2212x1659
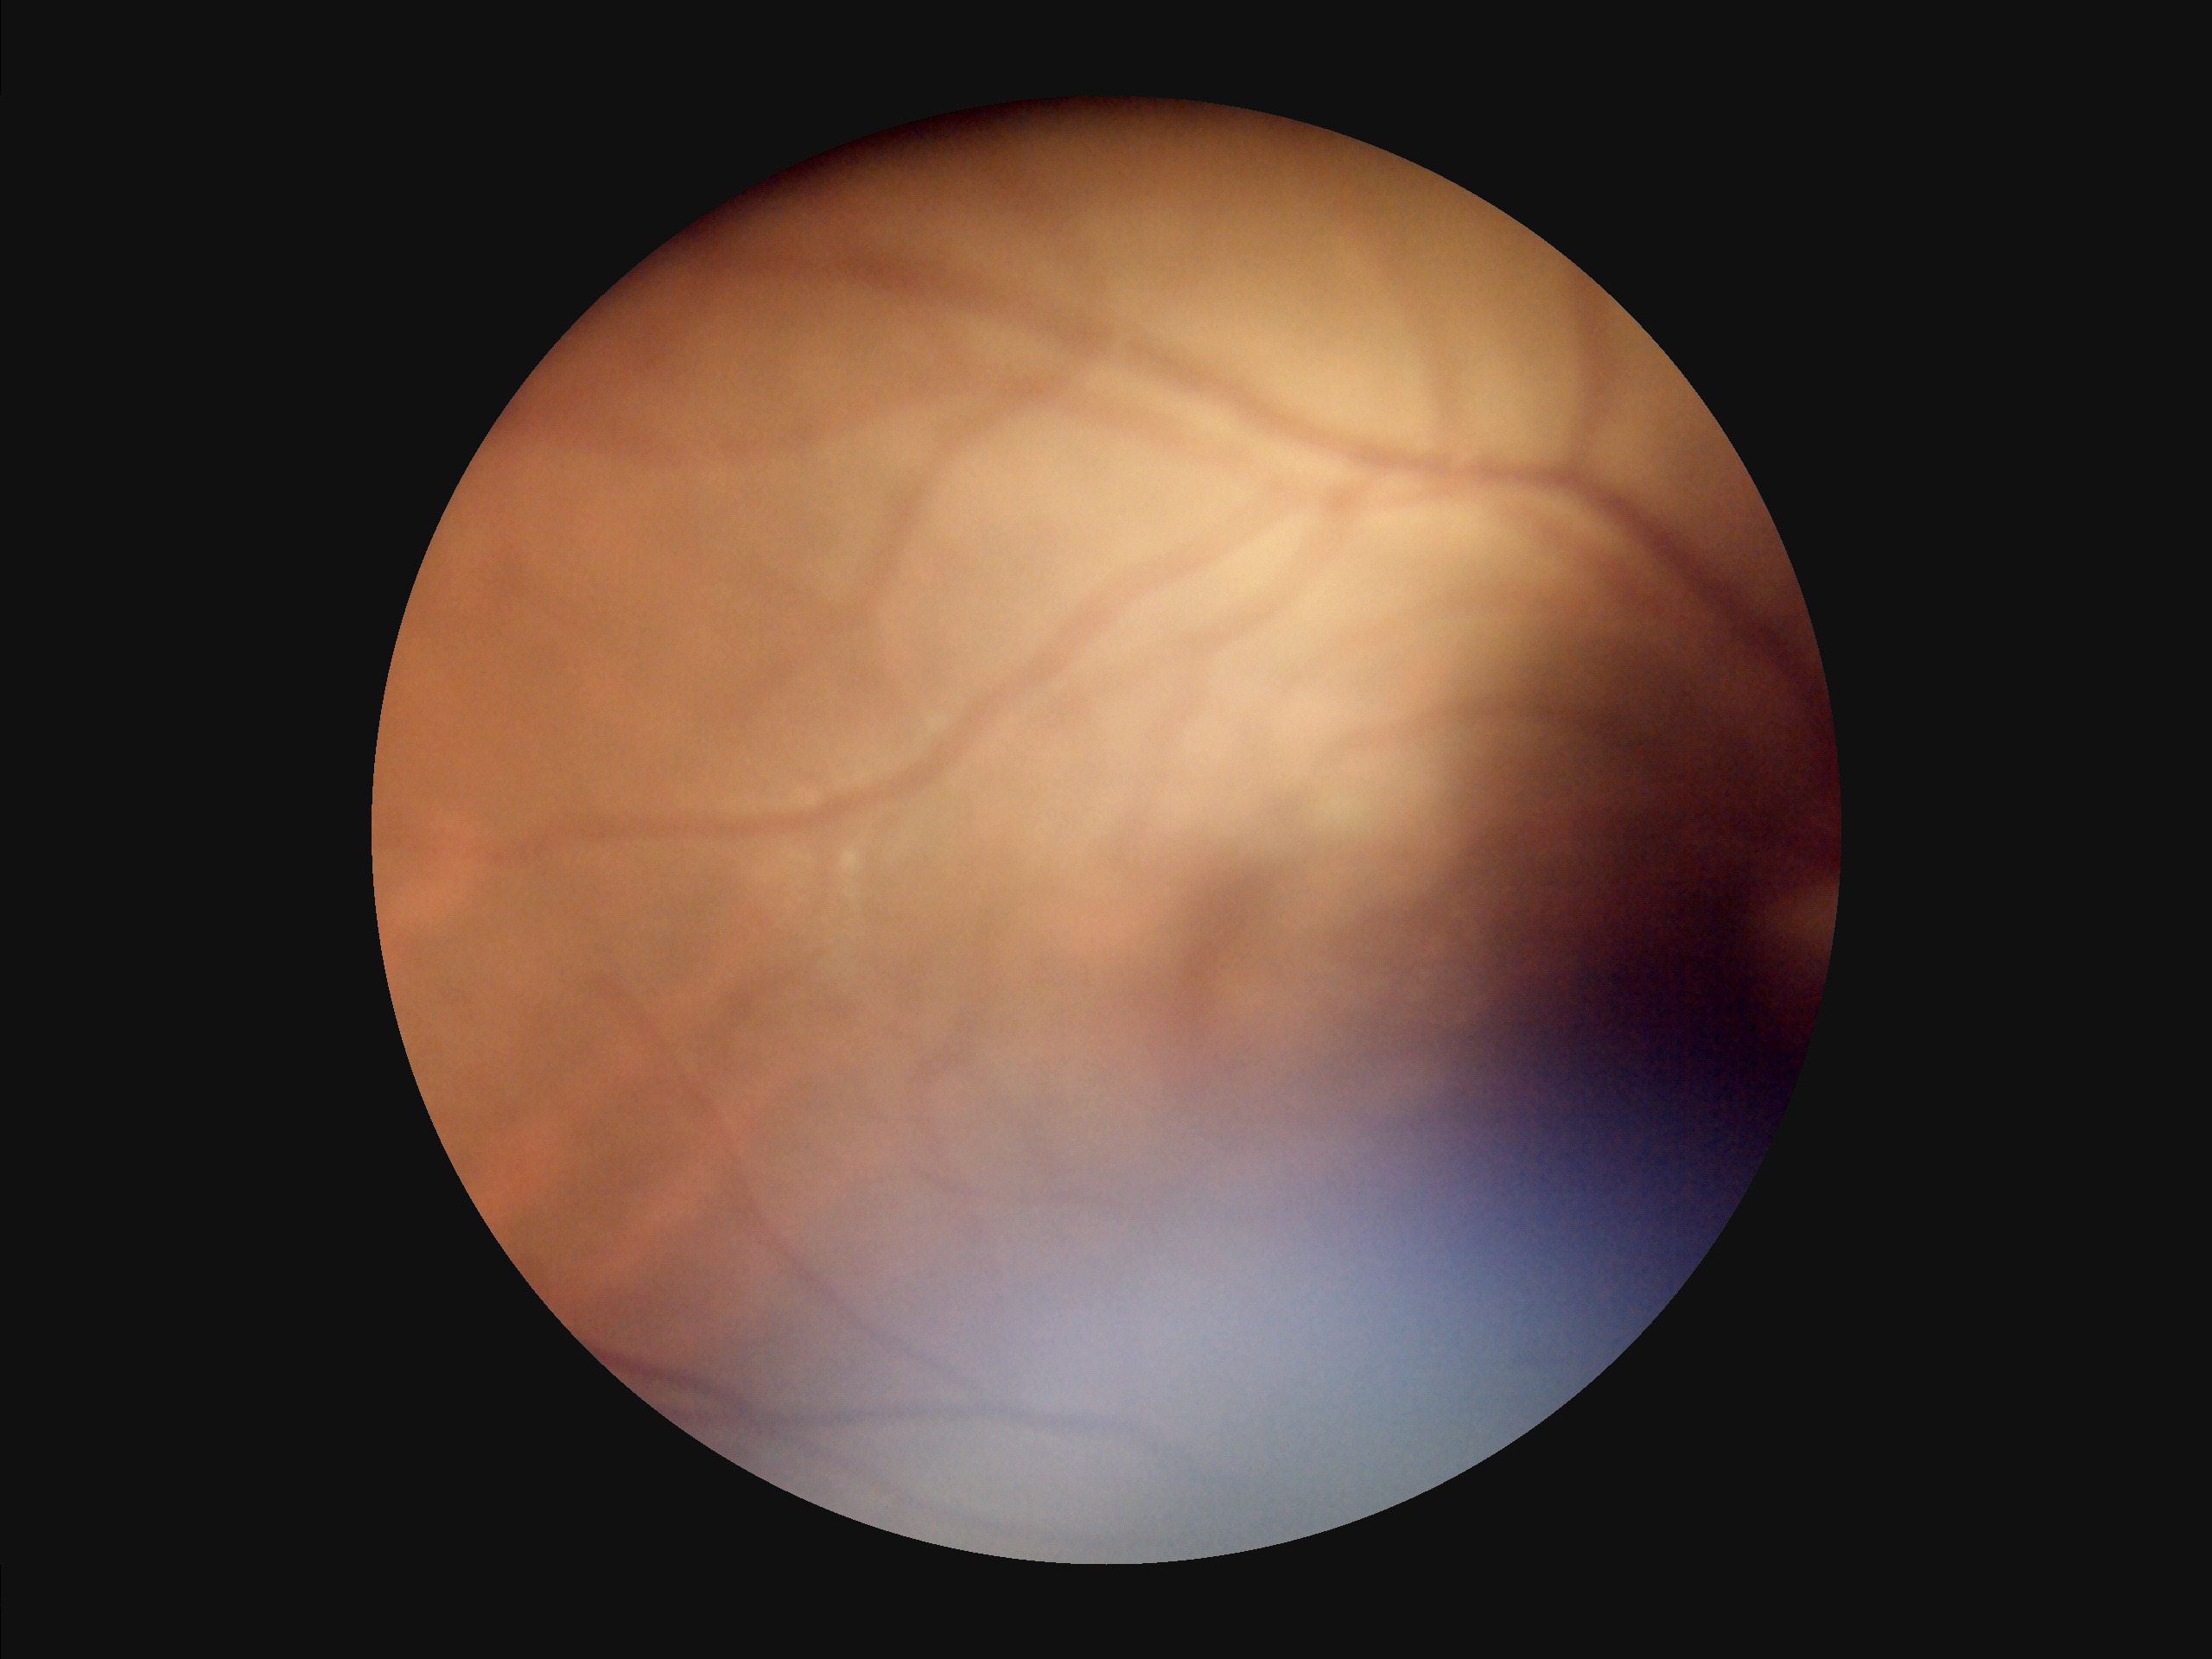

There is over- or under-exposure or a color cast.
Contrast is low.
Image quality is inadequate for diagnostic use.
Reduced sharpness with visible blur.